130° field of view (Natus RetCam Envision) · 1440x1080px · pediatric wide-field fundus photograph
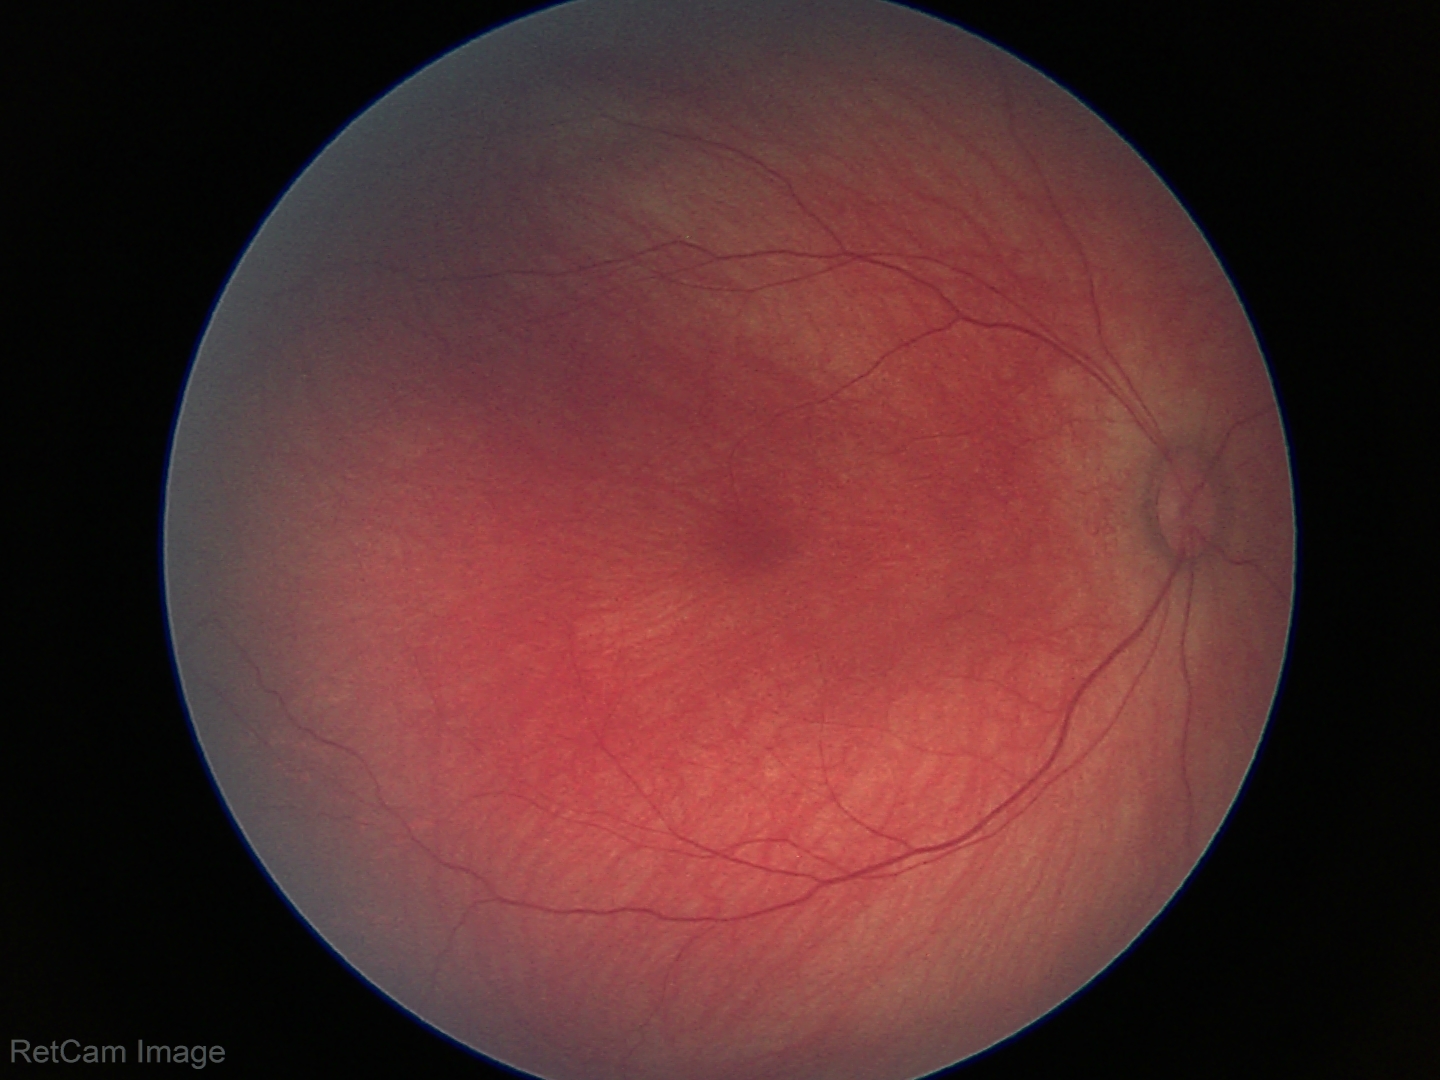

Normal screening examination.